Pediatric retinal photograph (wide-field).
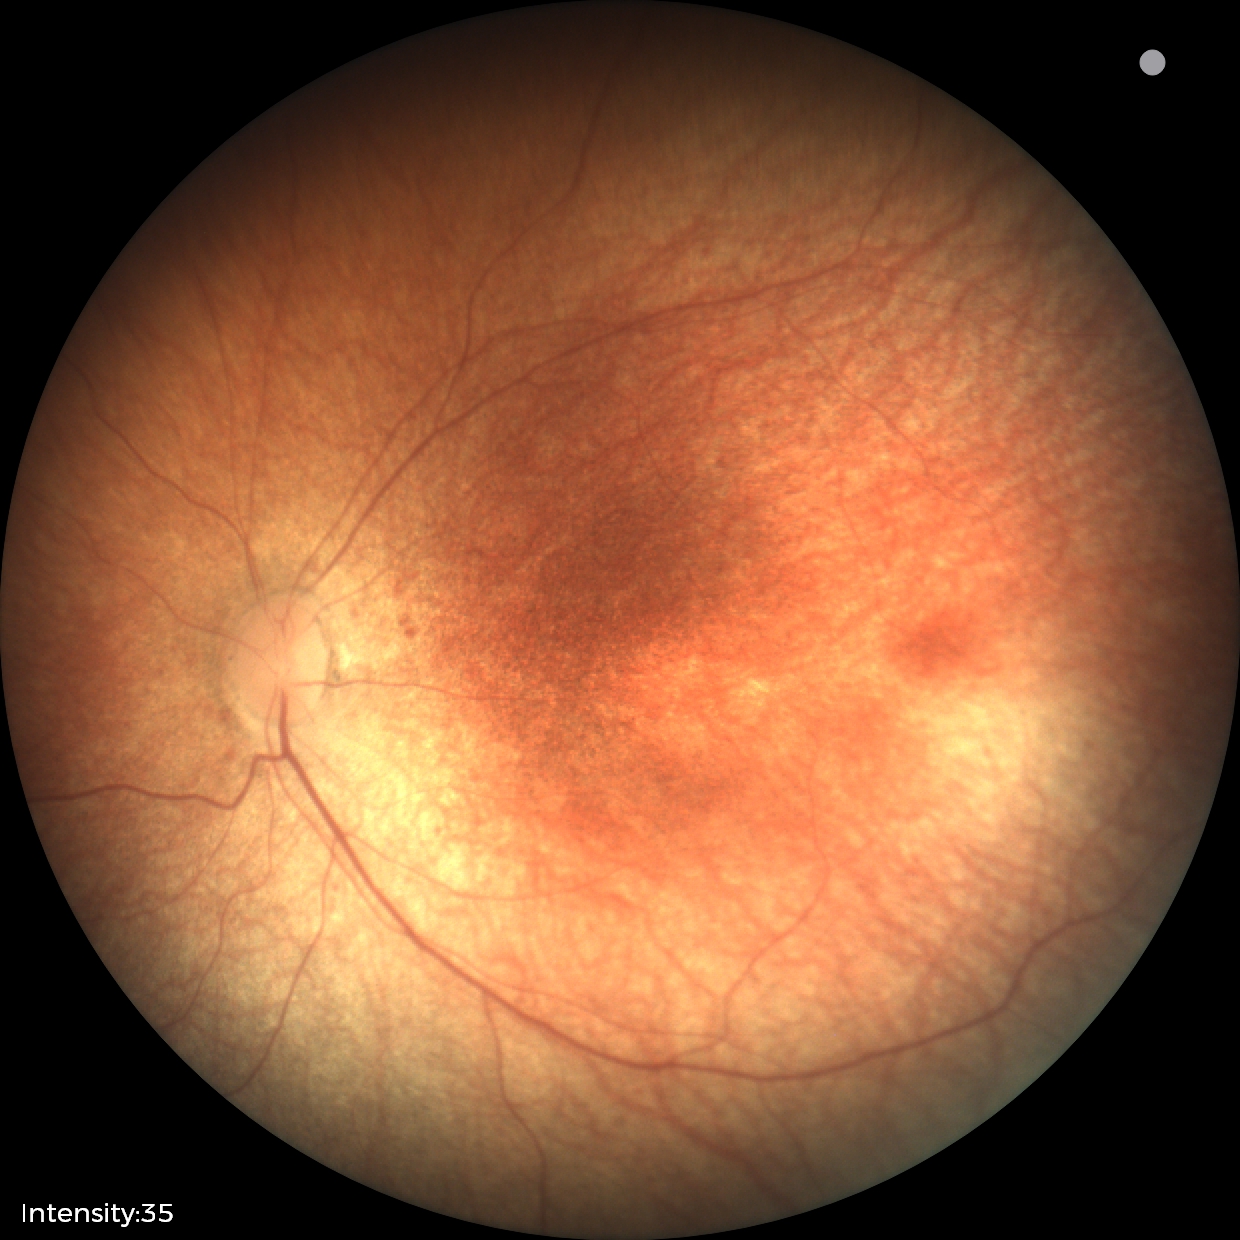
Impression = no abnormalities